Color fundus photograph. 2048x1536px:
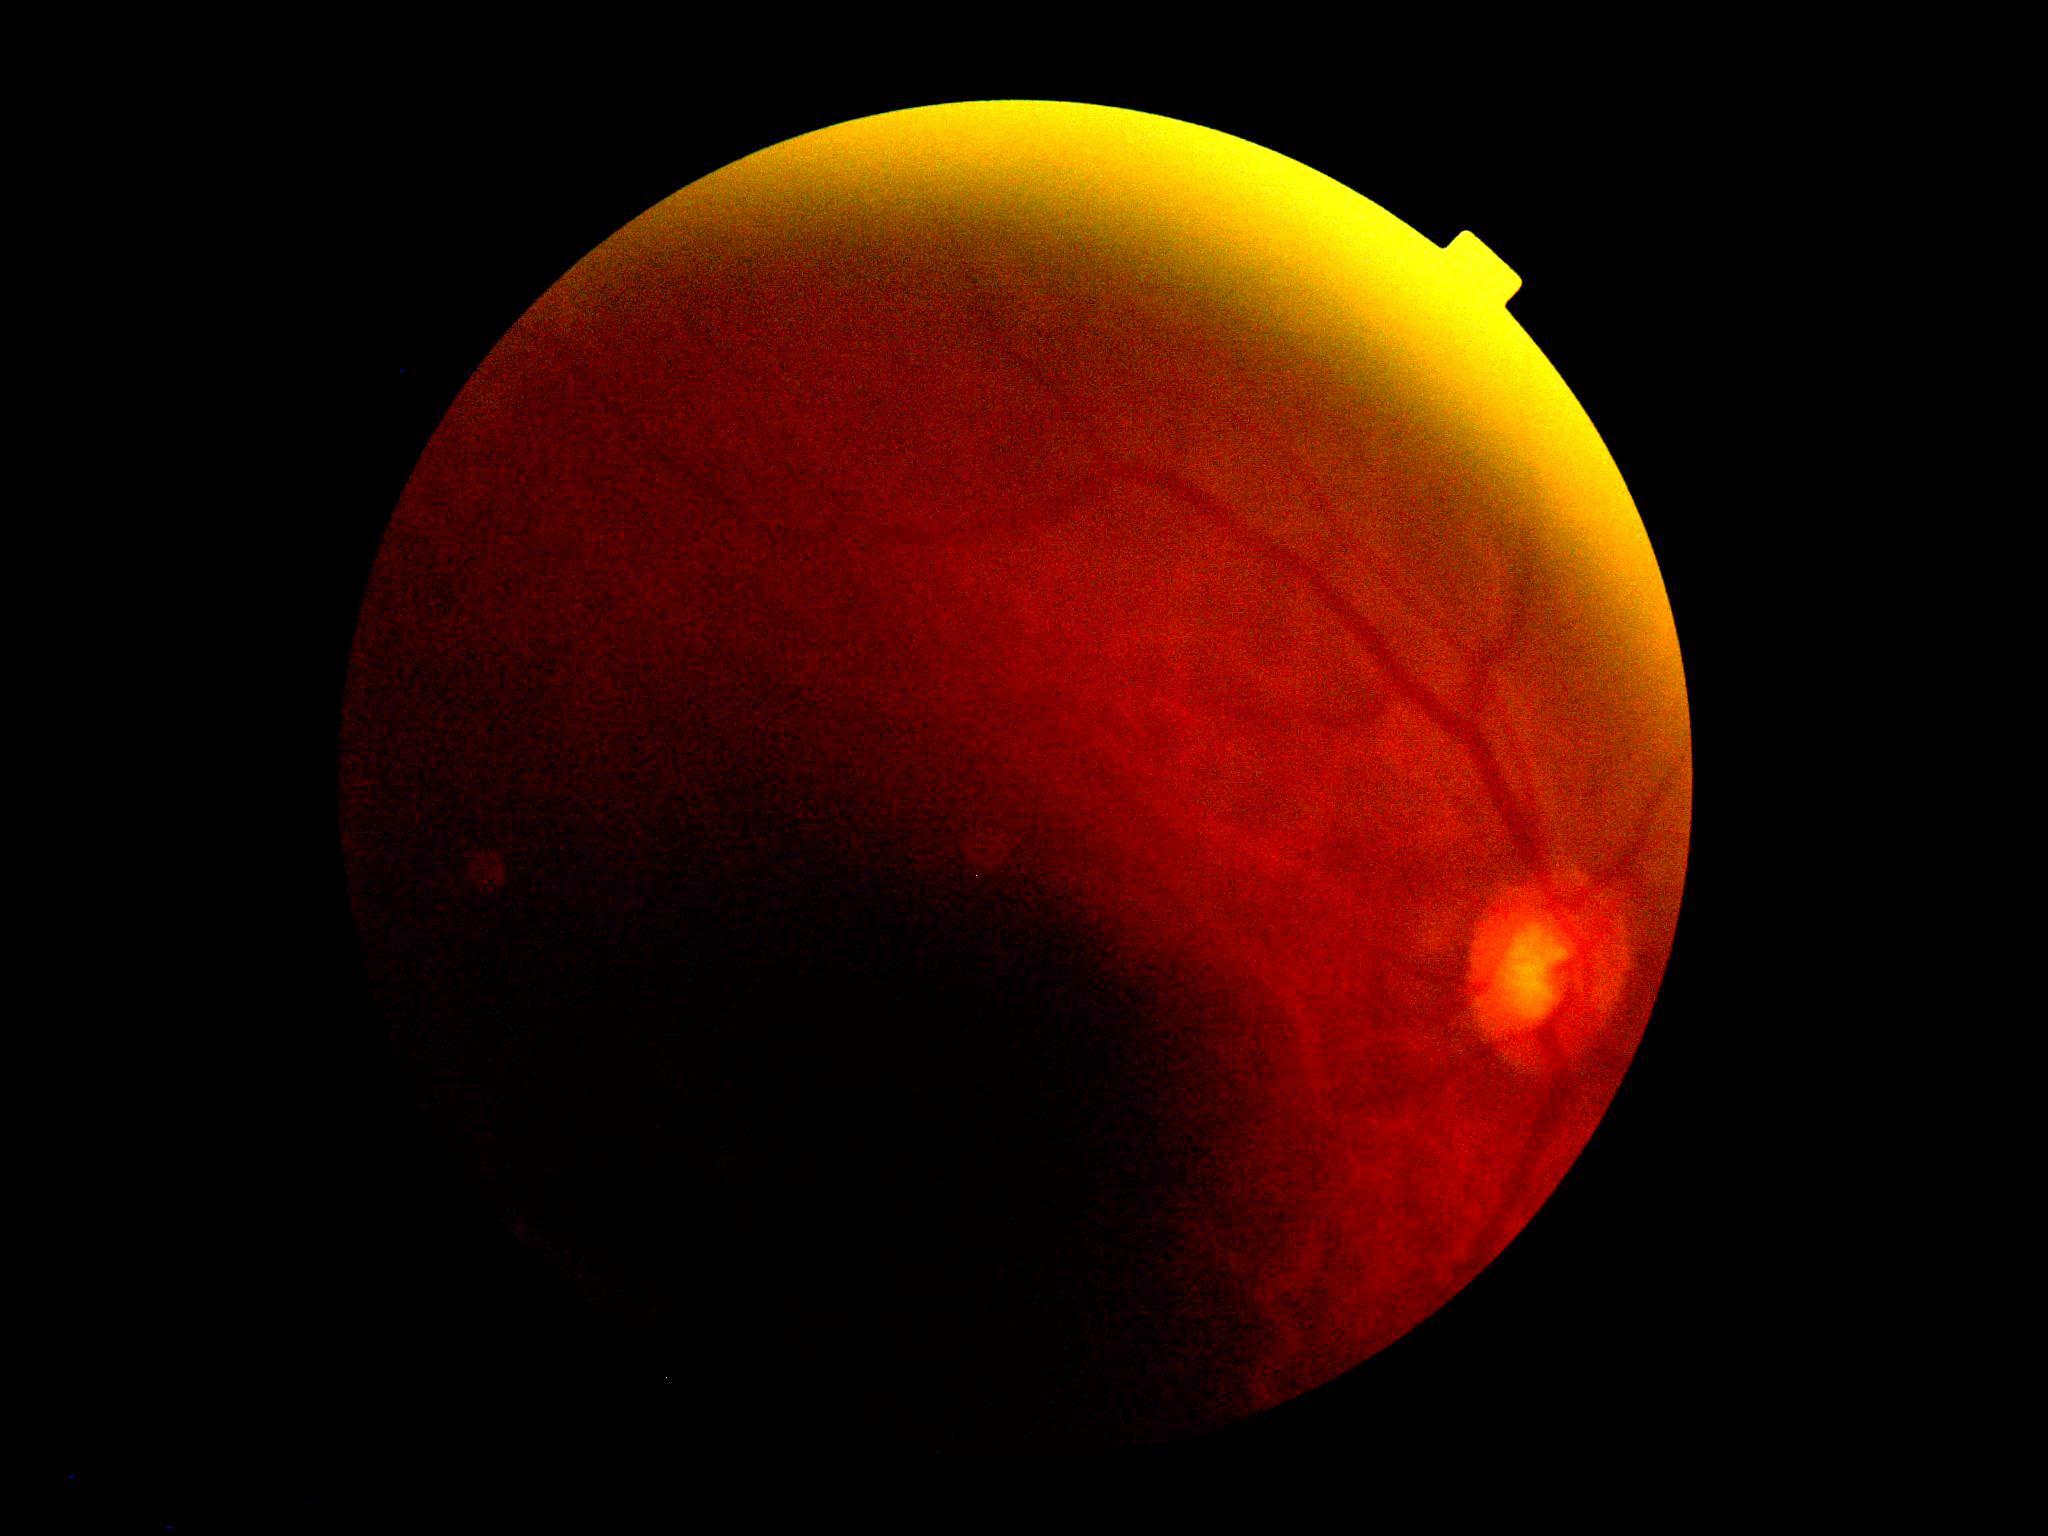 DR stage: ungradable